1725 x 1721 pixels; fundus photo; 45° FOV.
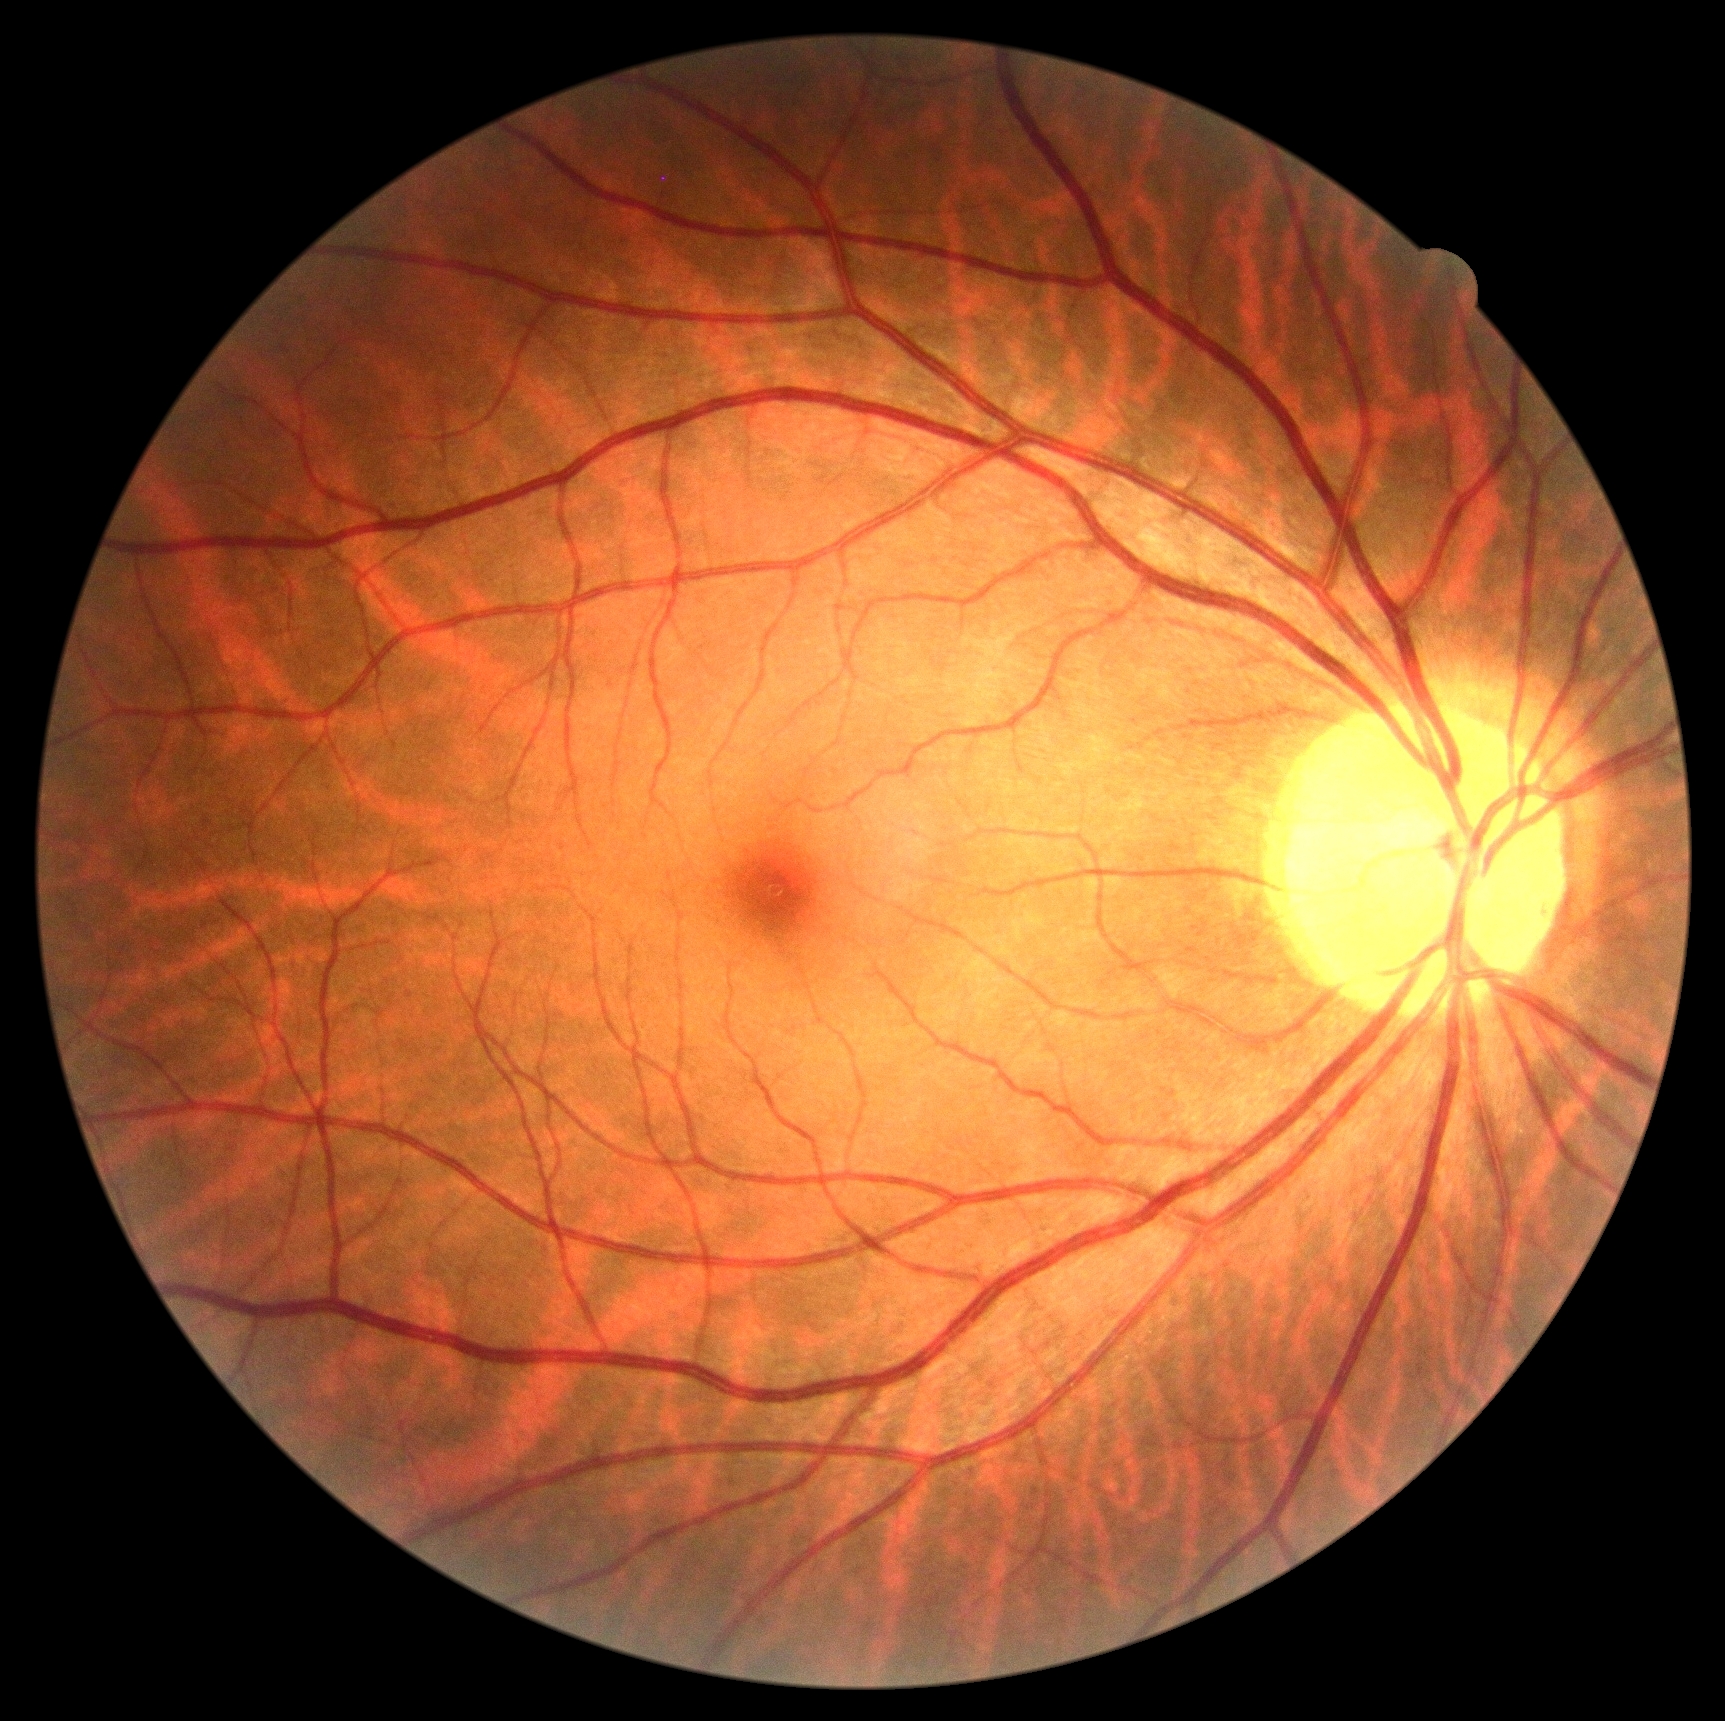
DR severity is grade 0 (no apparent retinopathy) — no visible signs of diabetic retinopathy. No DR findings.